FOV: 45 degrees, 848 by 848 pixels — 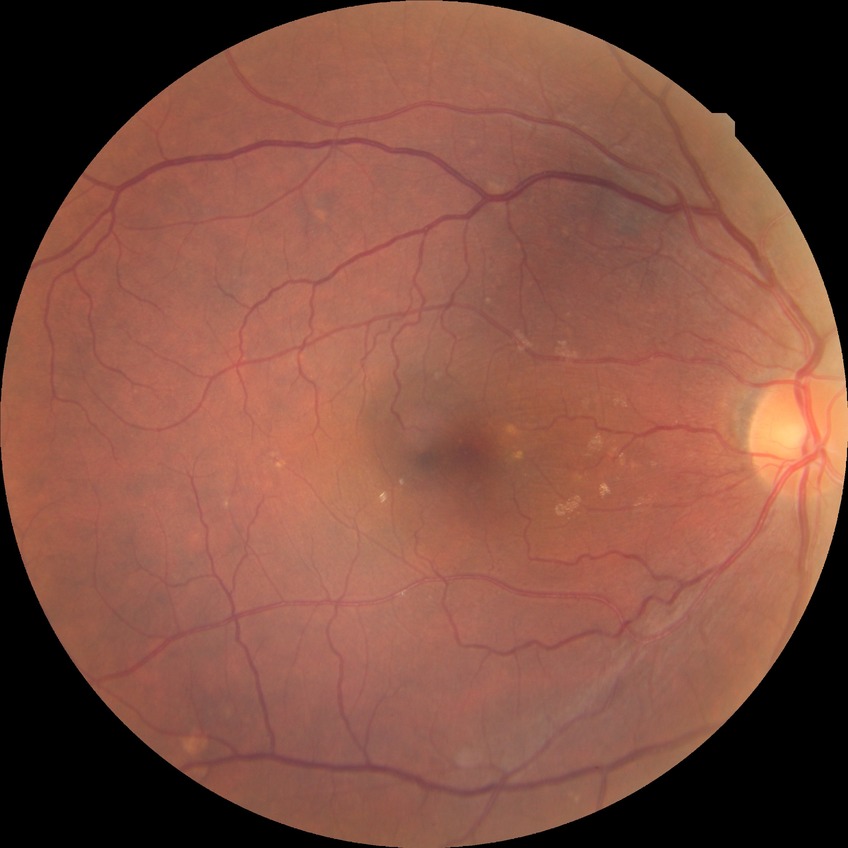
diabetic retinopathy (DR): no diabetic retinopathy (NDR).